848 by 848 pixels · NIDEK AFC-230 fundus camera · nonmydriatic fundus photograph · diabetic retinopathy graded by the modified Davis classification · posterior pole color fundus photograph: 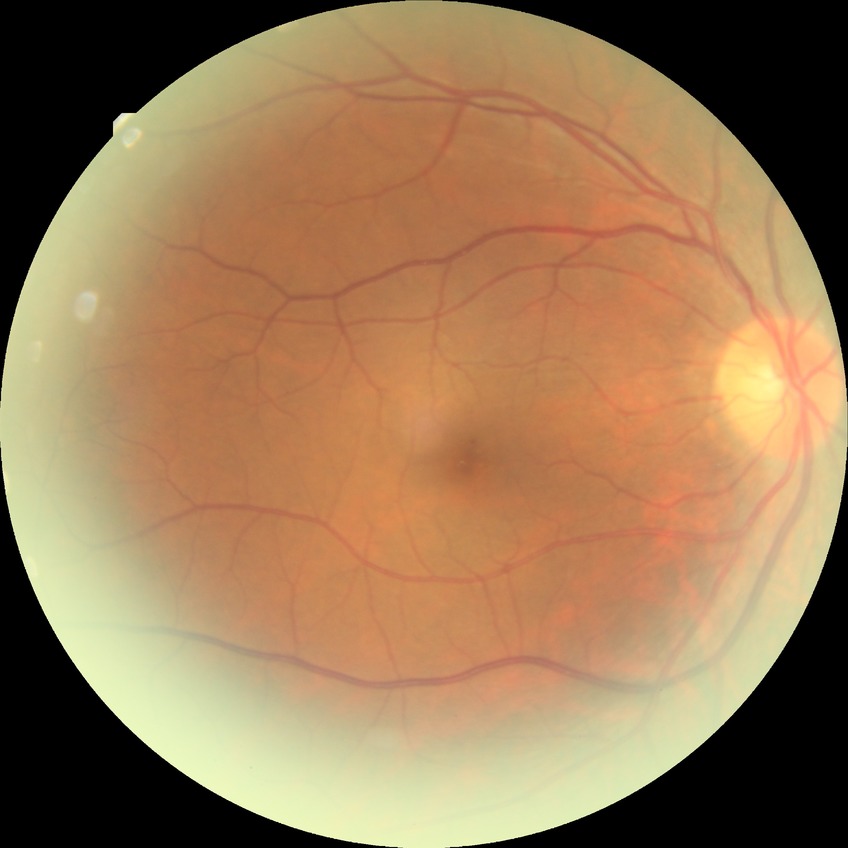

Findings:
- Davis grade — NDR